45-degree field of view, 2048 x 1536 pixels.
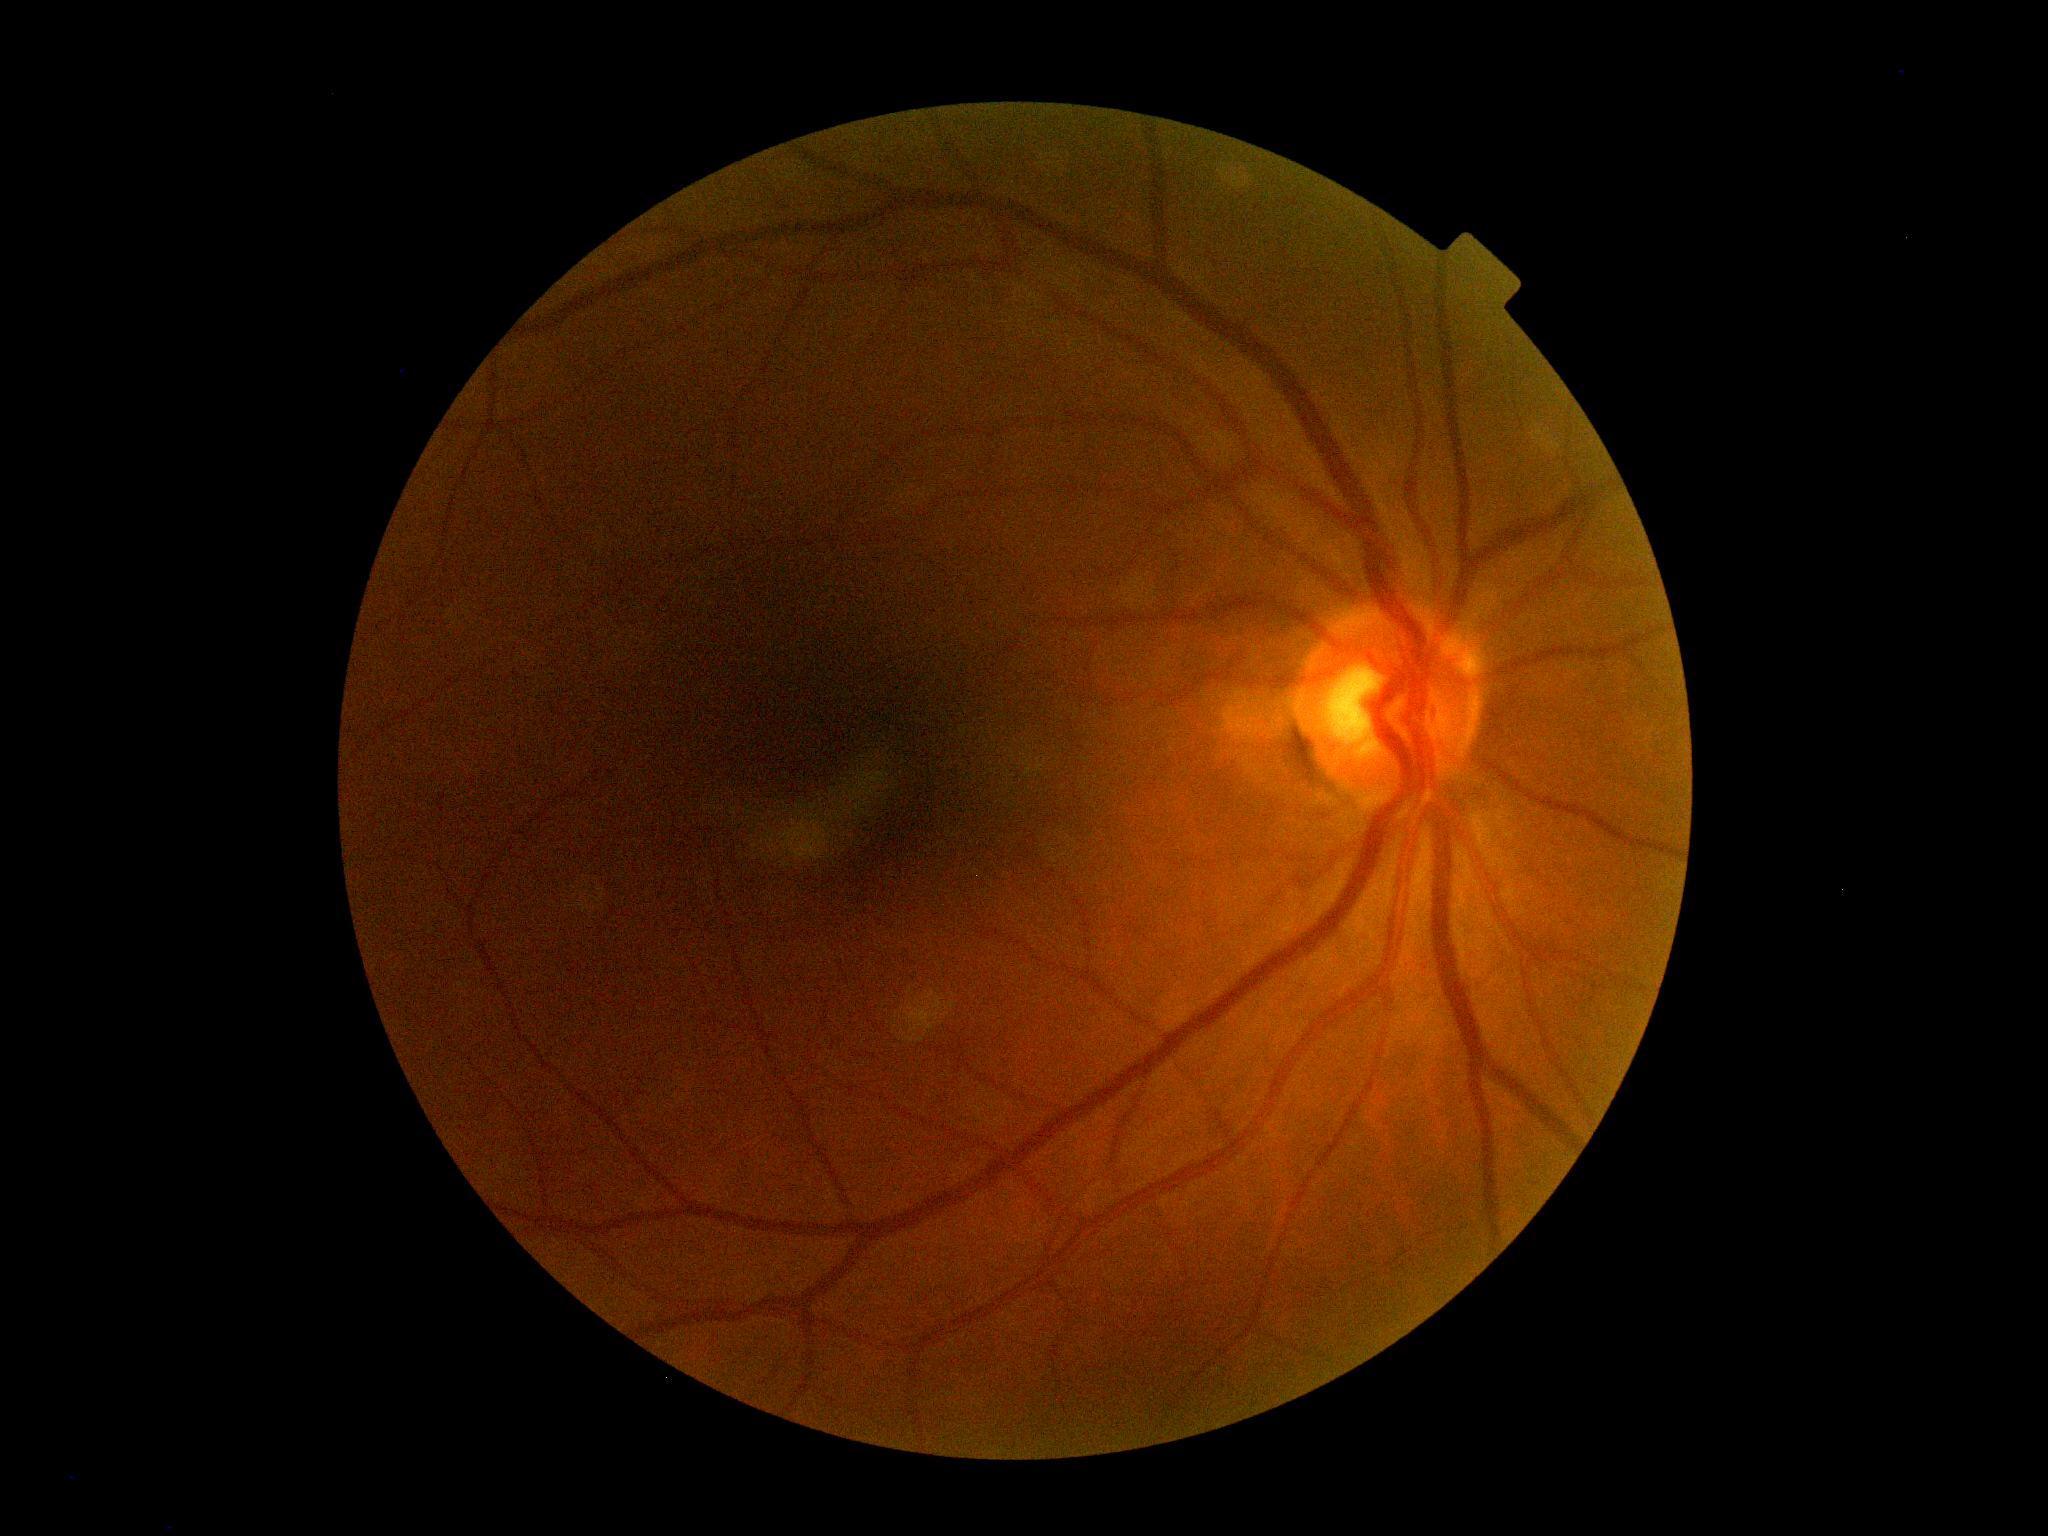

DR is 0 — no visible signs of diabetic retinopathy.